Wide-field contact fundus photograph of an infant · image size 640x480:
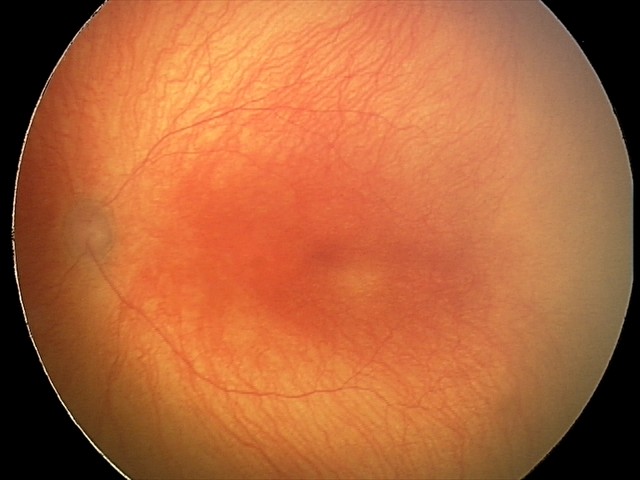
With plus disease.
Examination diagnosed as aggressive retinopathy of prematurity (A-ROP).